Non-mydriatic · optic disc region crop:
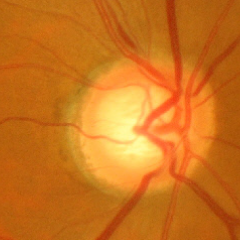

Glaucomatous optic neuropathy is present. Glaucoma diagnosis = advanced glaucomatous optic neuropathy.